1240 x 1240 pixels · camera: Phoenix ICON (100° FOV) · infant wide-field fundus photograph:
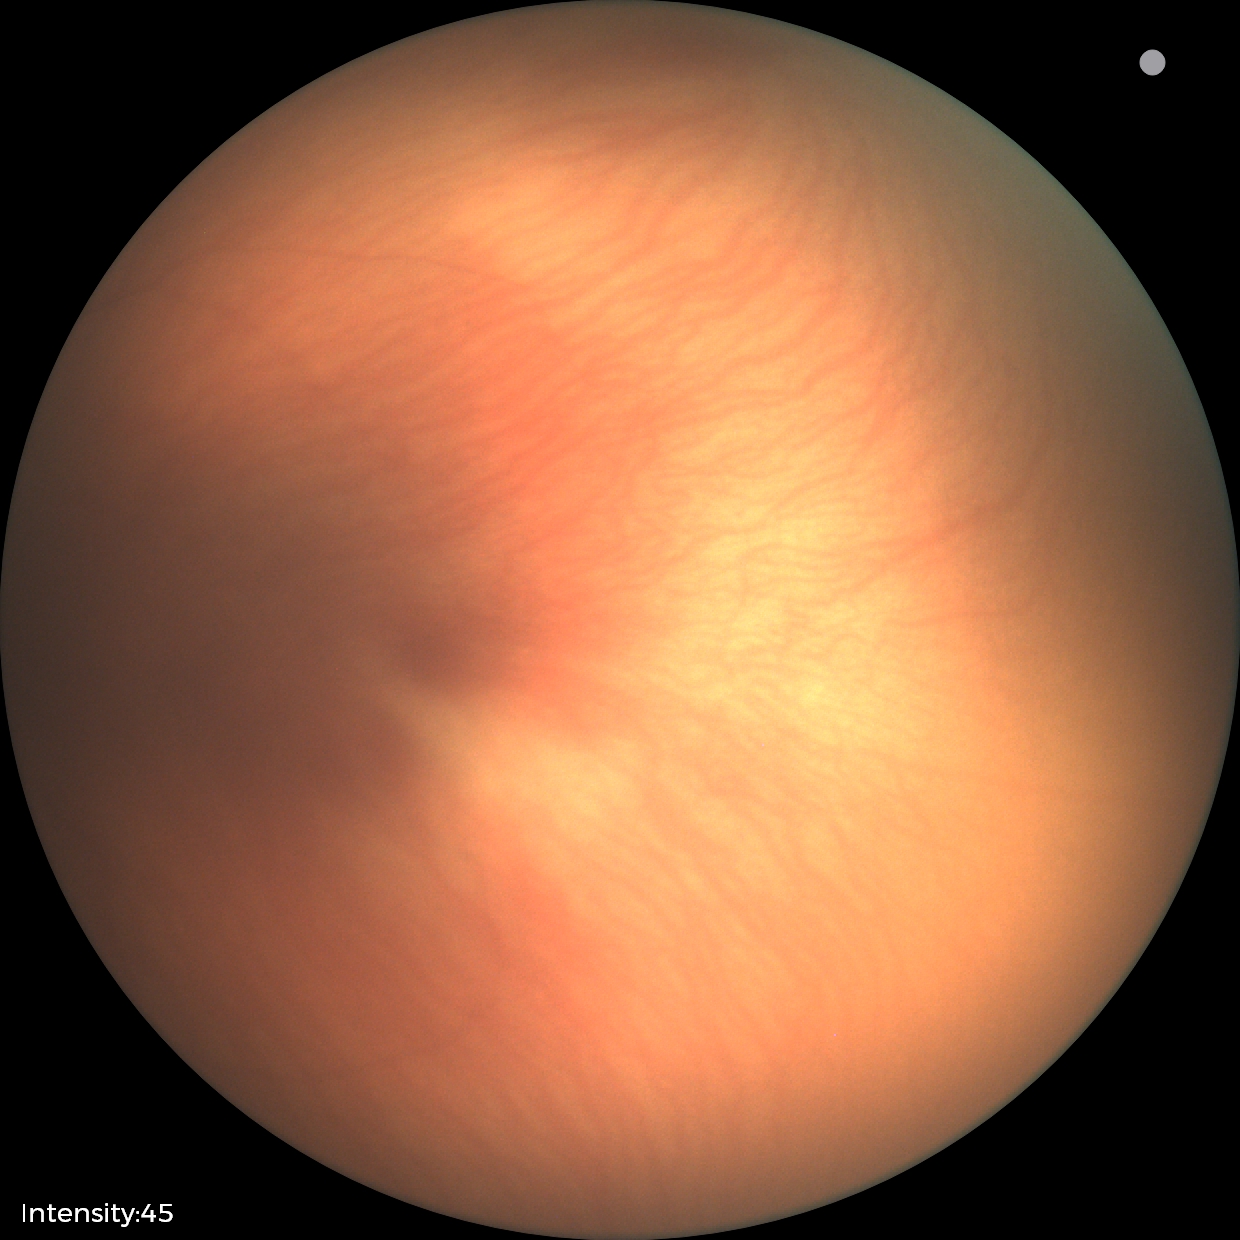
Impression: no abnormalities.